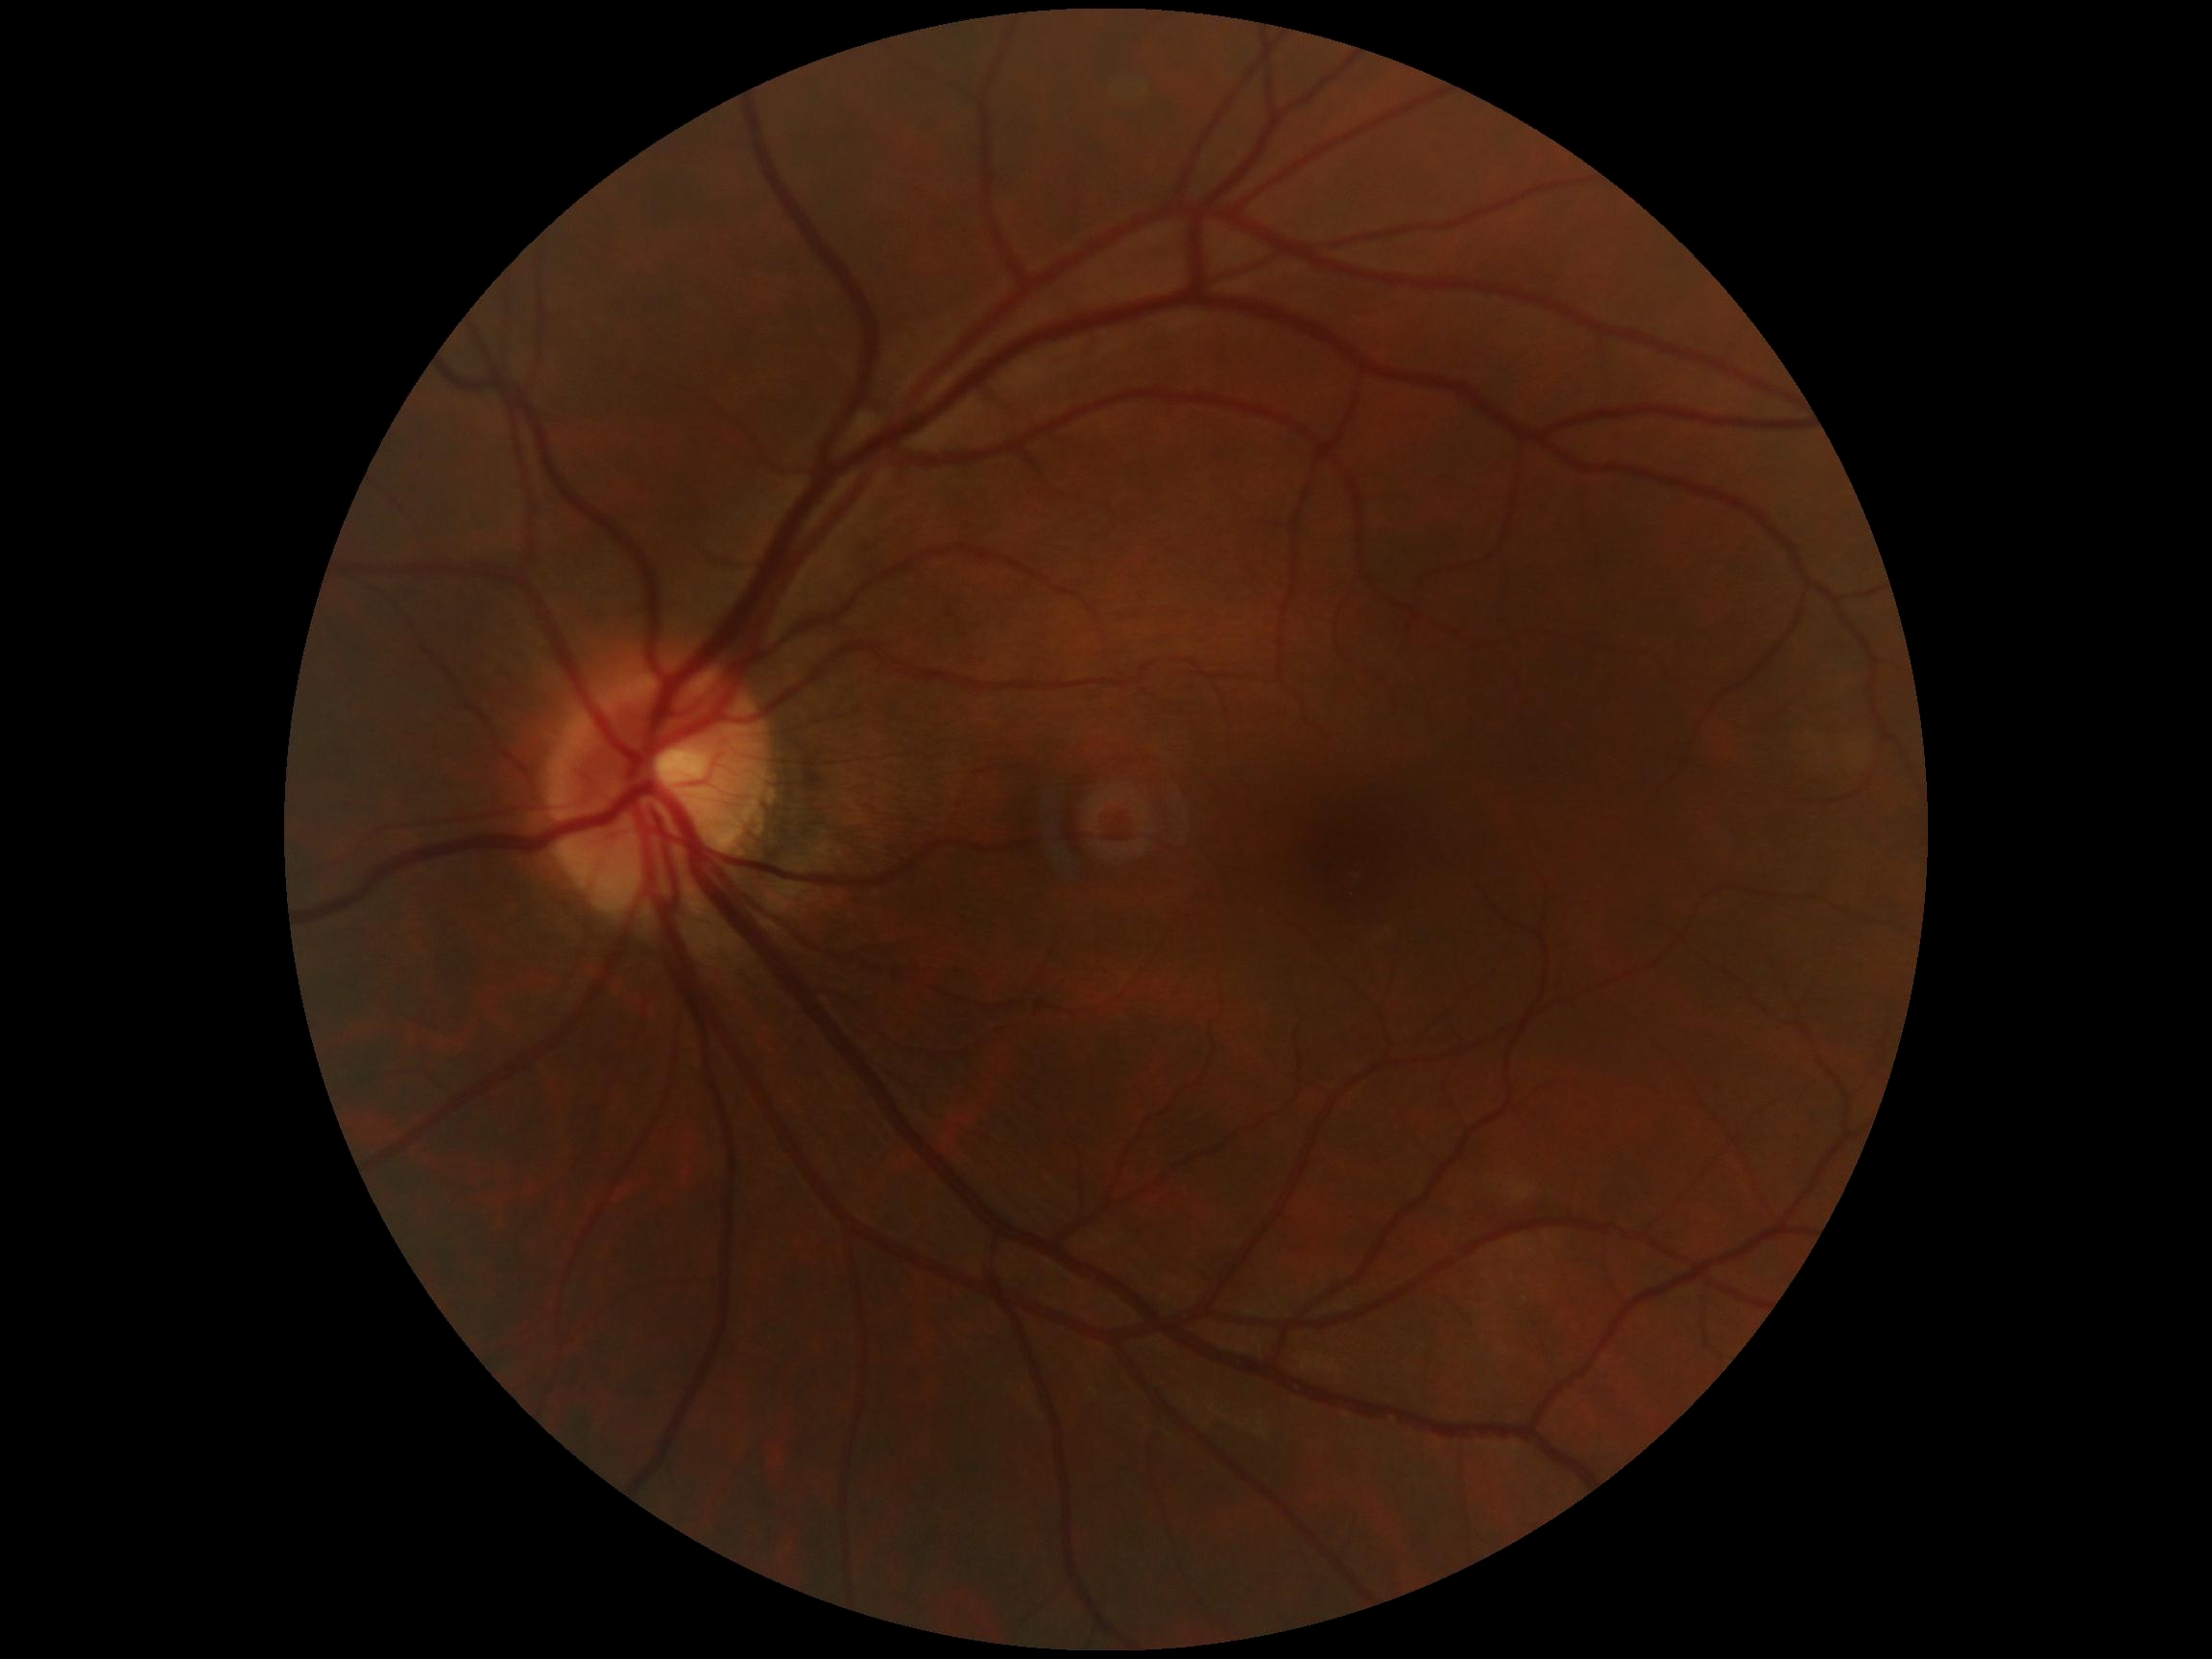
Diabetic retinopathy is no apparent retinopathy (grade 0).